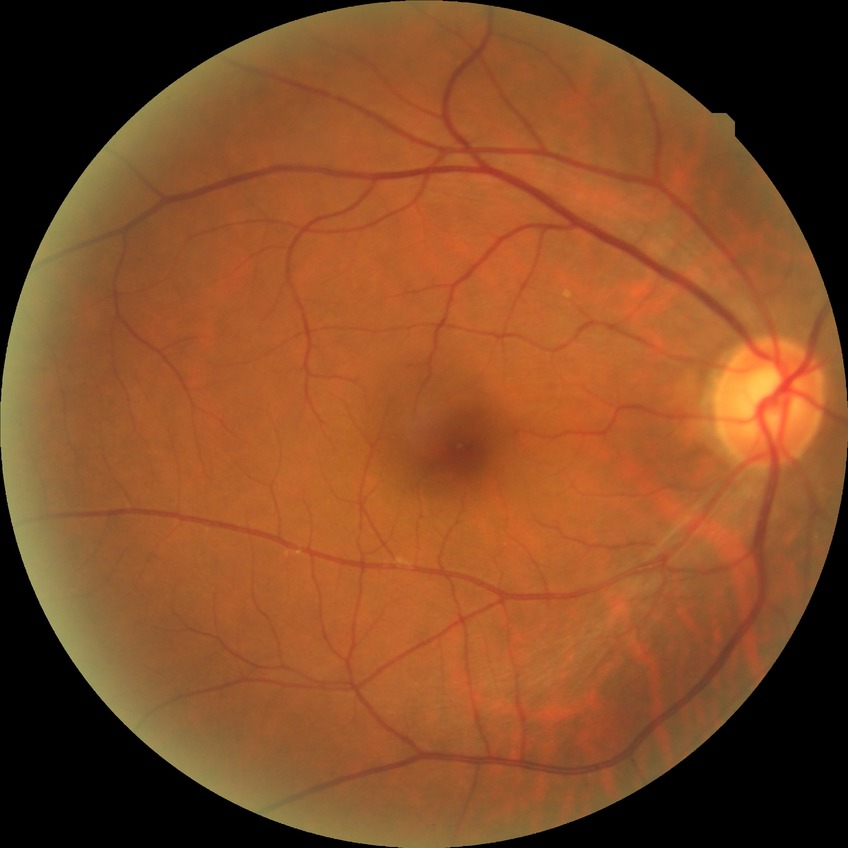

Diabetic retinopathy (DR) is no diabetic retinopathy (NDR).